NIDEK AFC-230, 45° field of view — 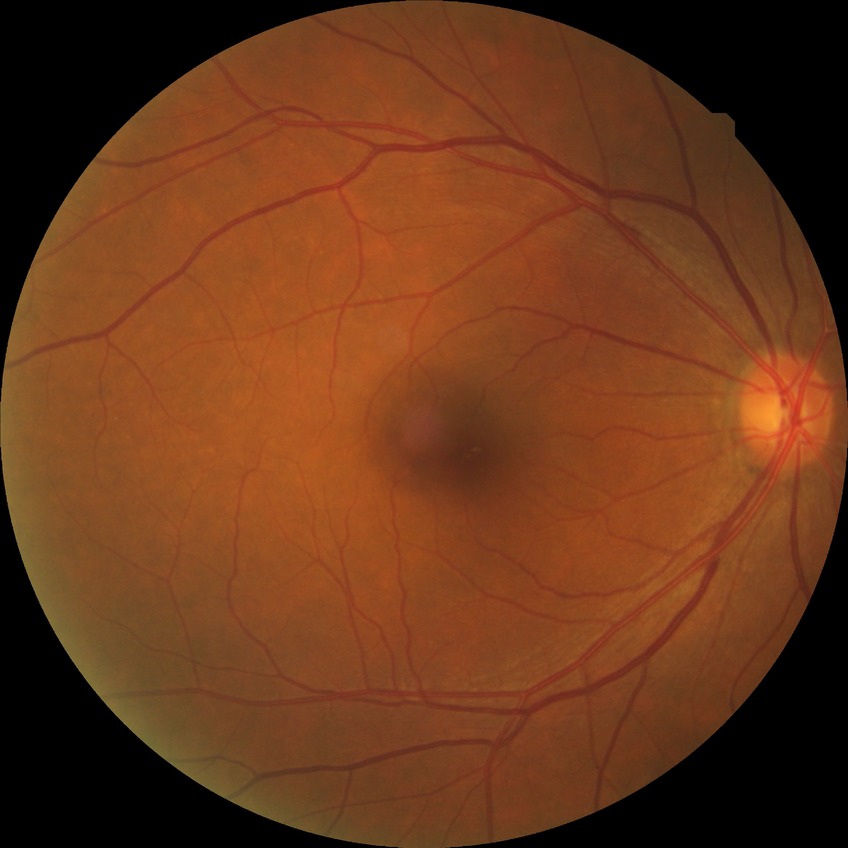 Davis grade: NDR.